Ultra-widefield fundus mosaic. 200° field of view. 1924 by 1556 pixels.
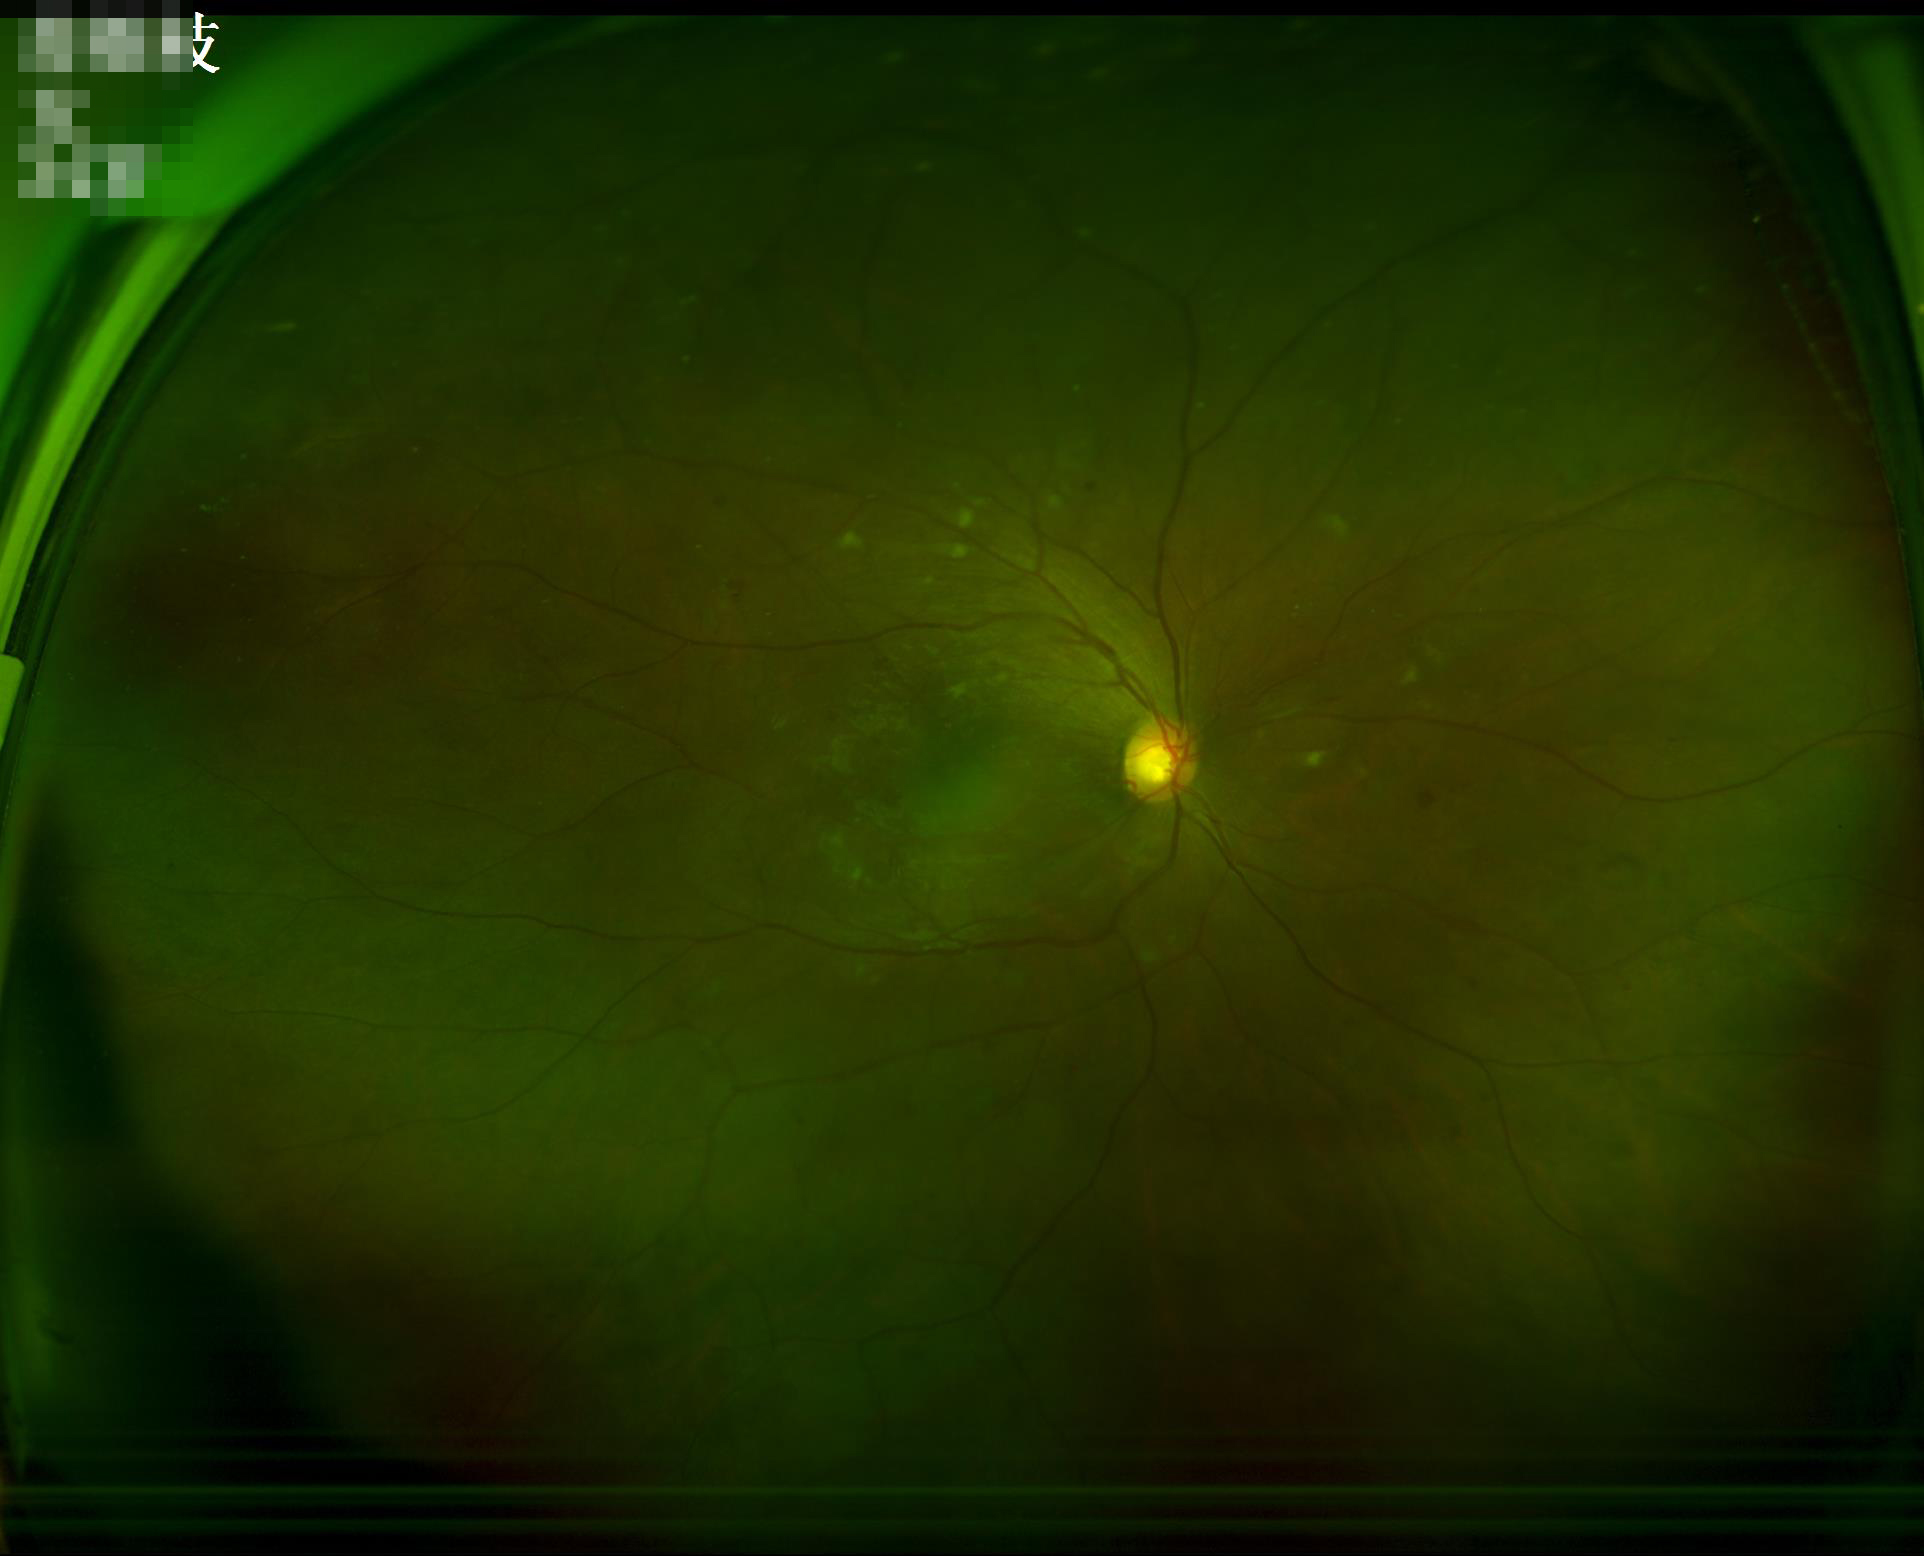

Quality assessment: illumination/color: even; overall: good; clarity: sharp.